Disc-centered field.
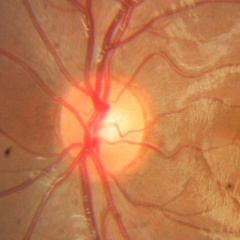
Demonstrates no evidence of glaucoma.